848x848, camera: NIDEK AFC-230, 45-degree field of view, diabetic retinopathy graded by the modified Davis classification, fundus photo, without pupil dilation
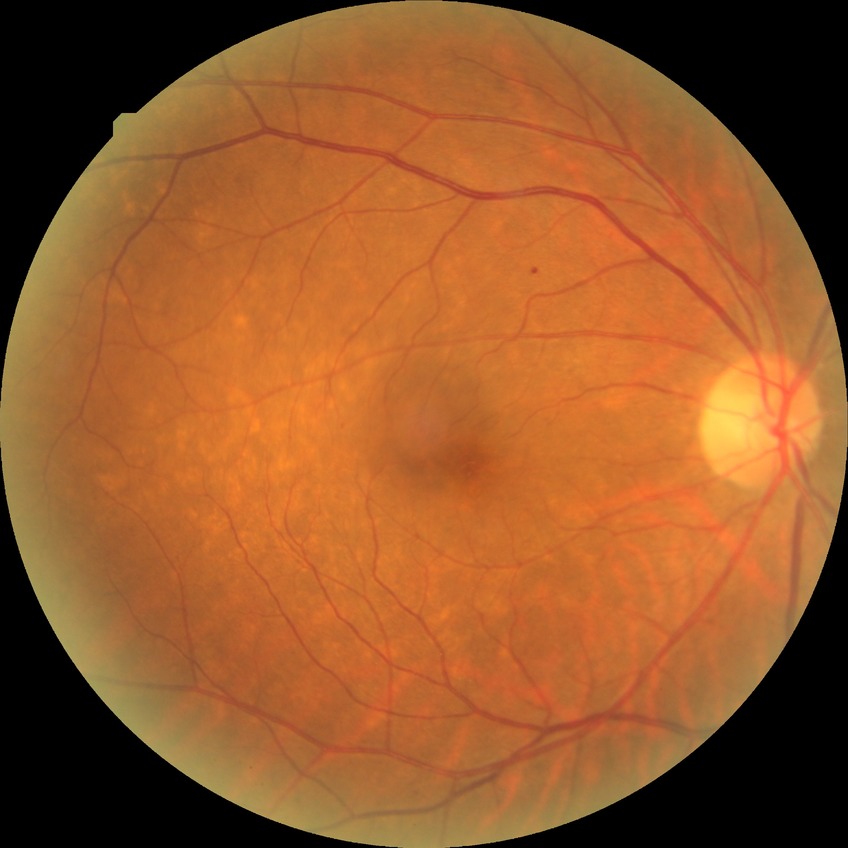

Diabetic retinopathy (DR) is SDR (simple diabetic retinopathy).